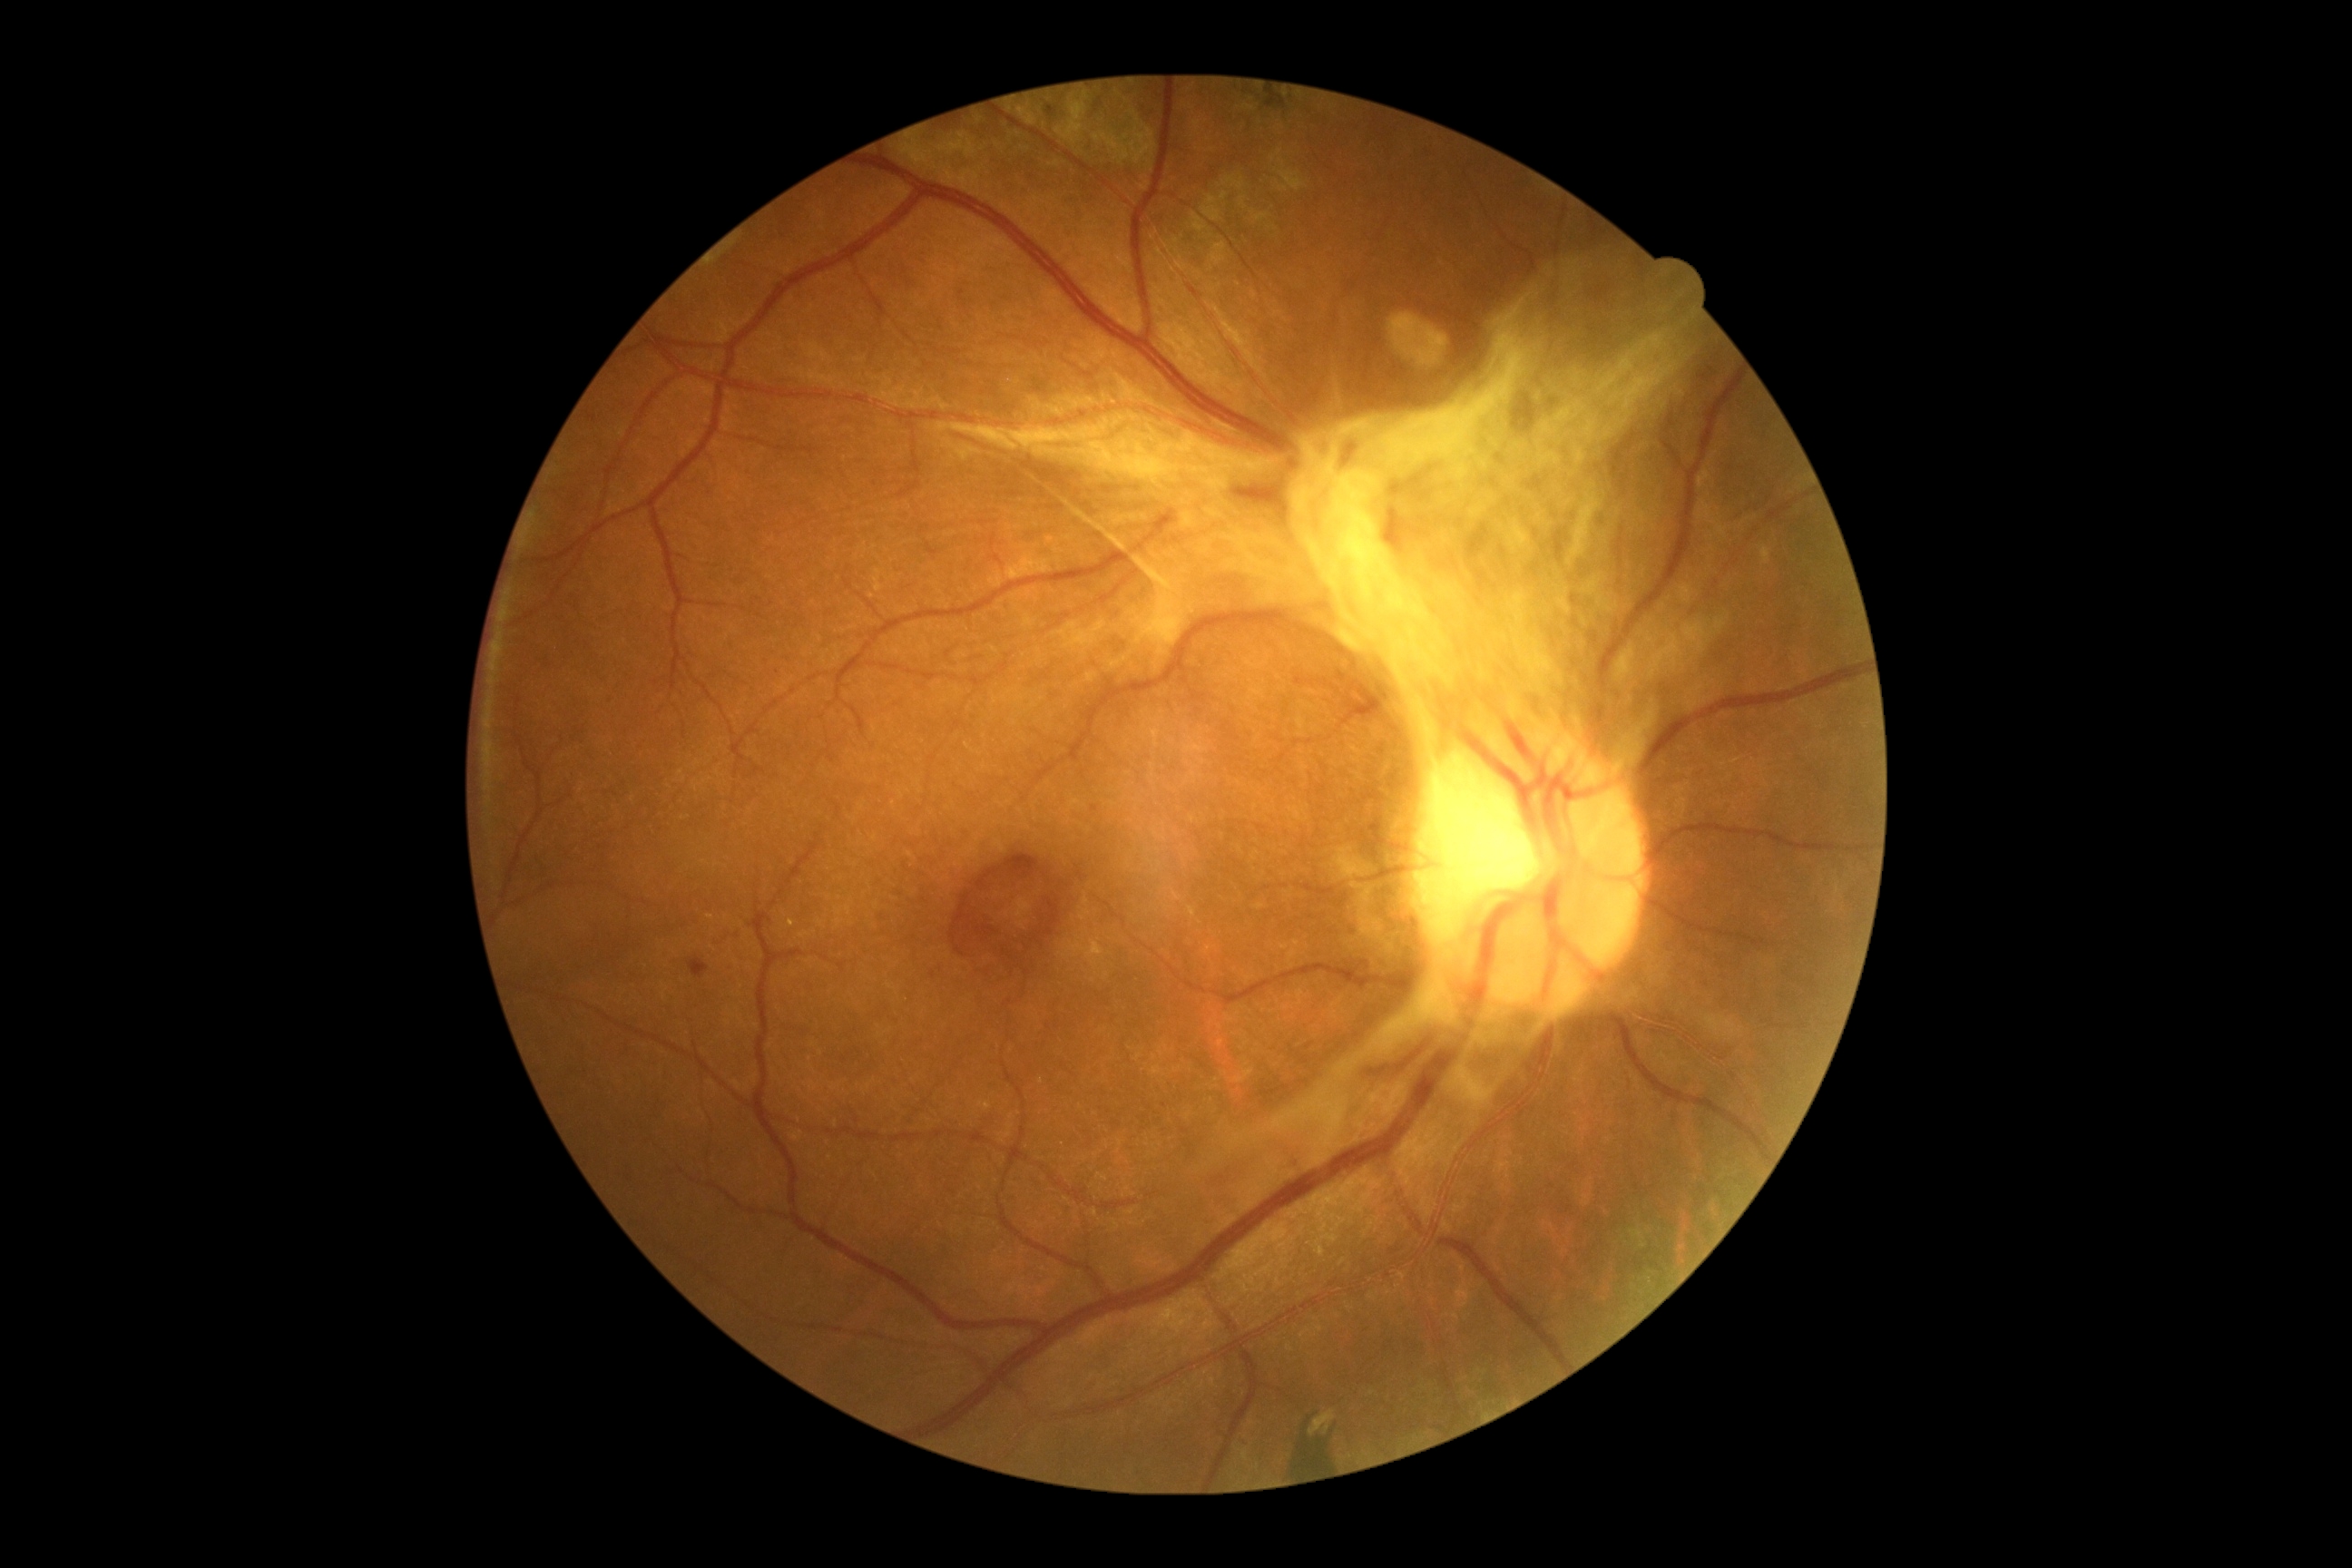

Disease class: proliferative diabetic retinopathy.
DR grade: PDR (4).